Color fundus photograph centered on the optic disc: 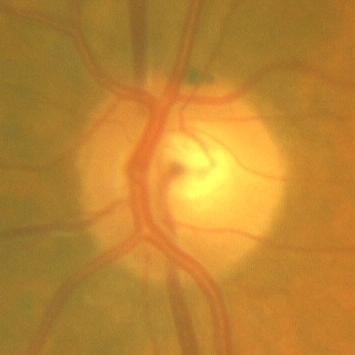

There is evidence of no glaucomatous findings.